Pediatric wide-field fundus photograph:
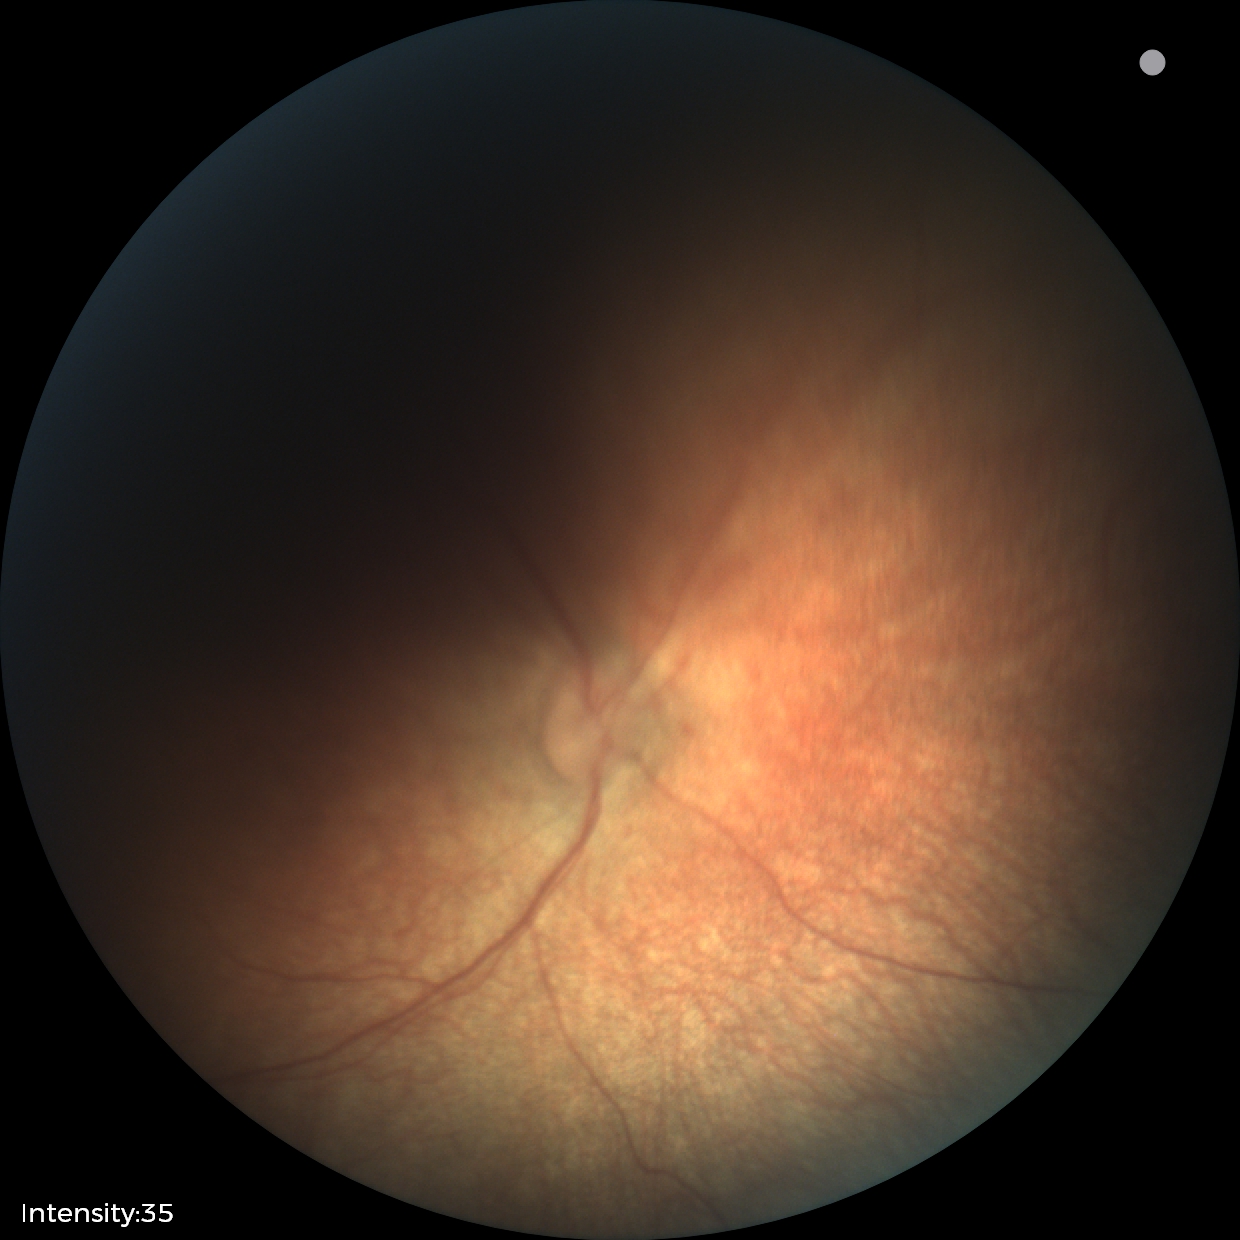 Normal screening examination.